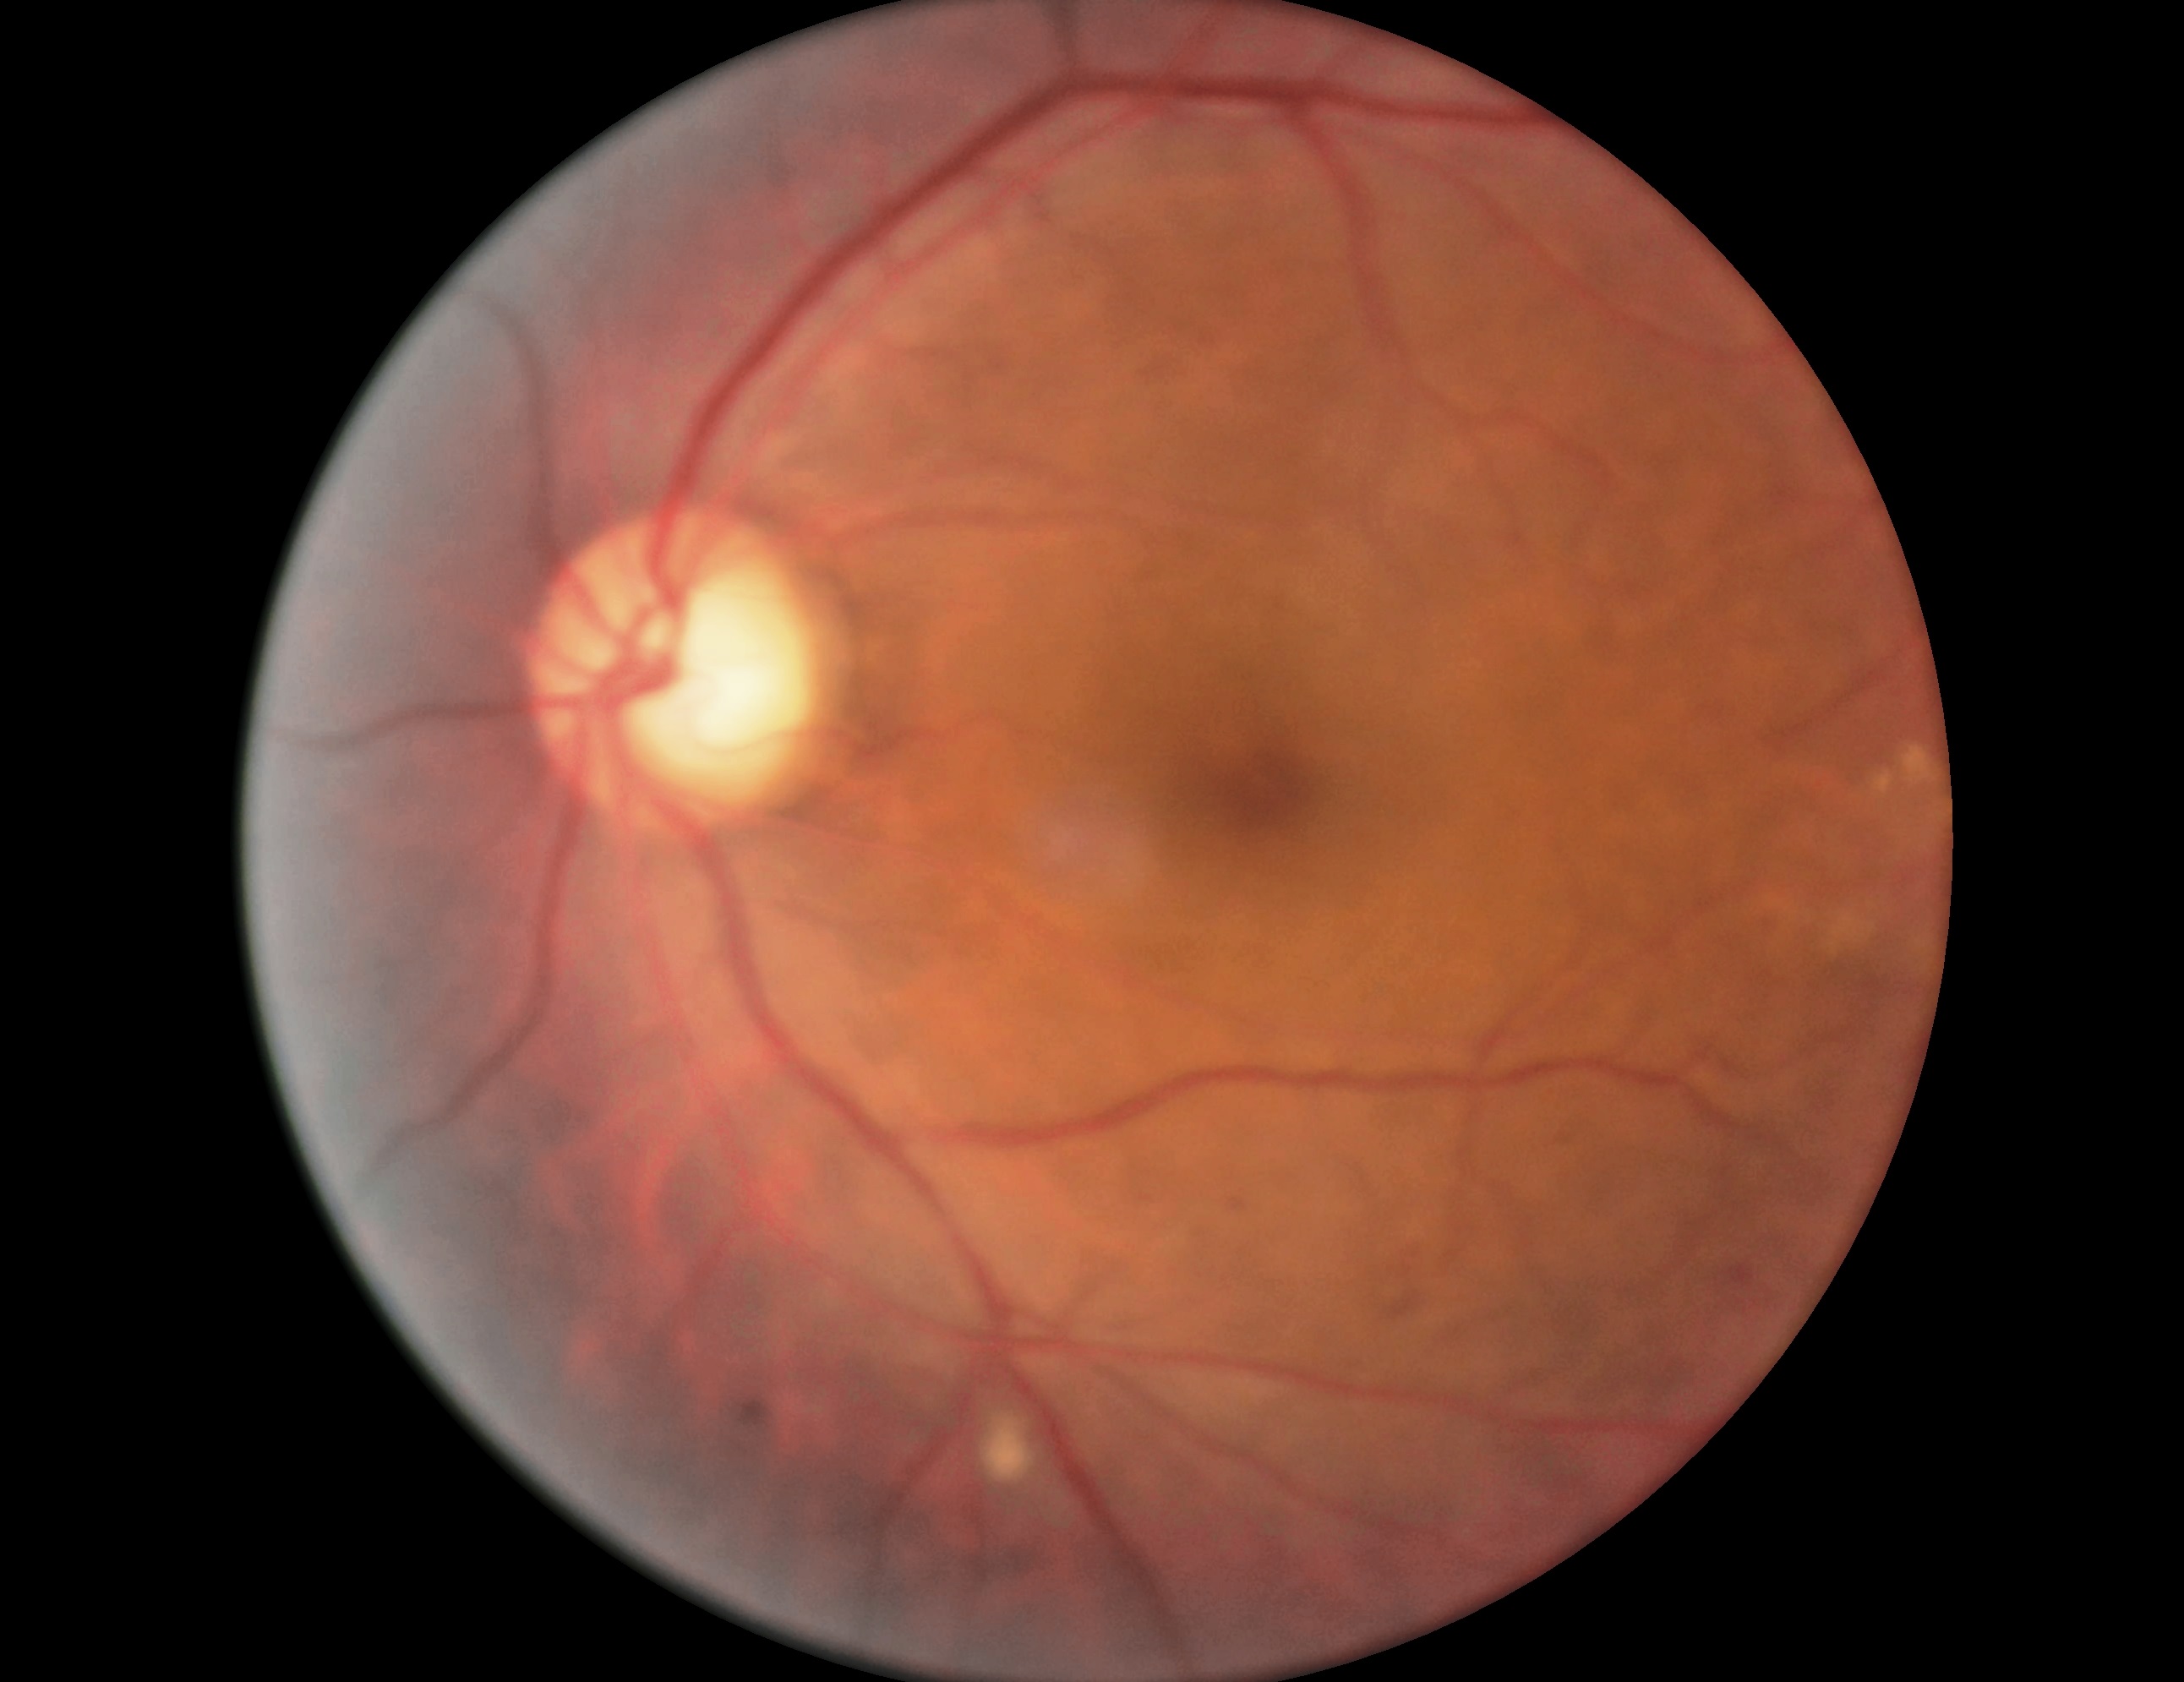
diabetic retinopathy grade: 2 (moderate NPDR) — more than just microaneurysms but less than severe NPDR